45-degree field of view
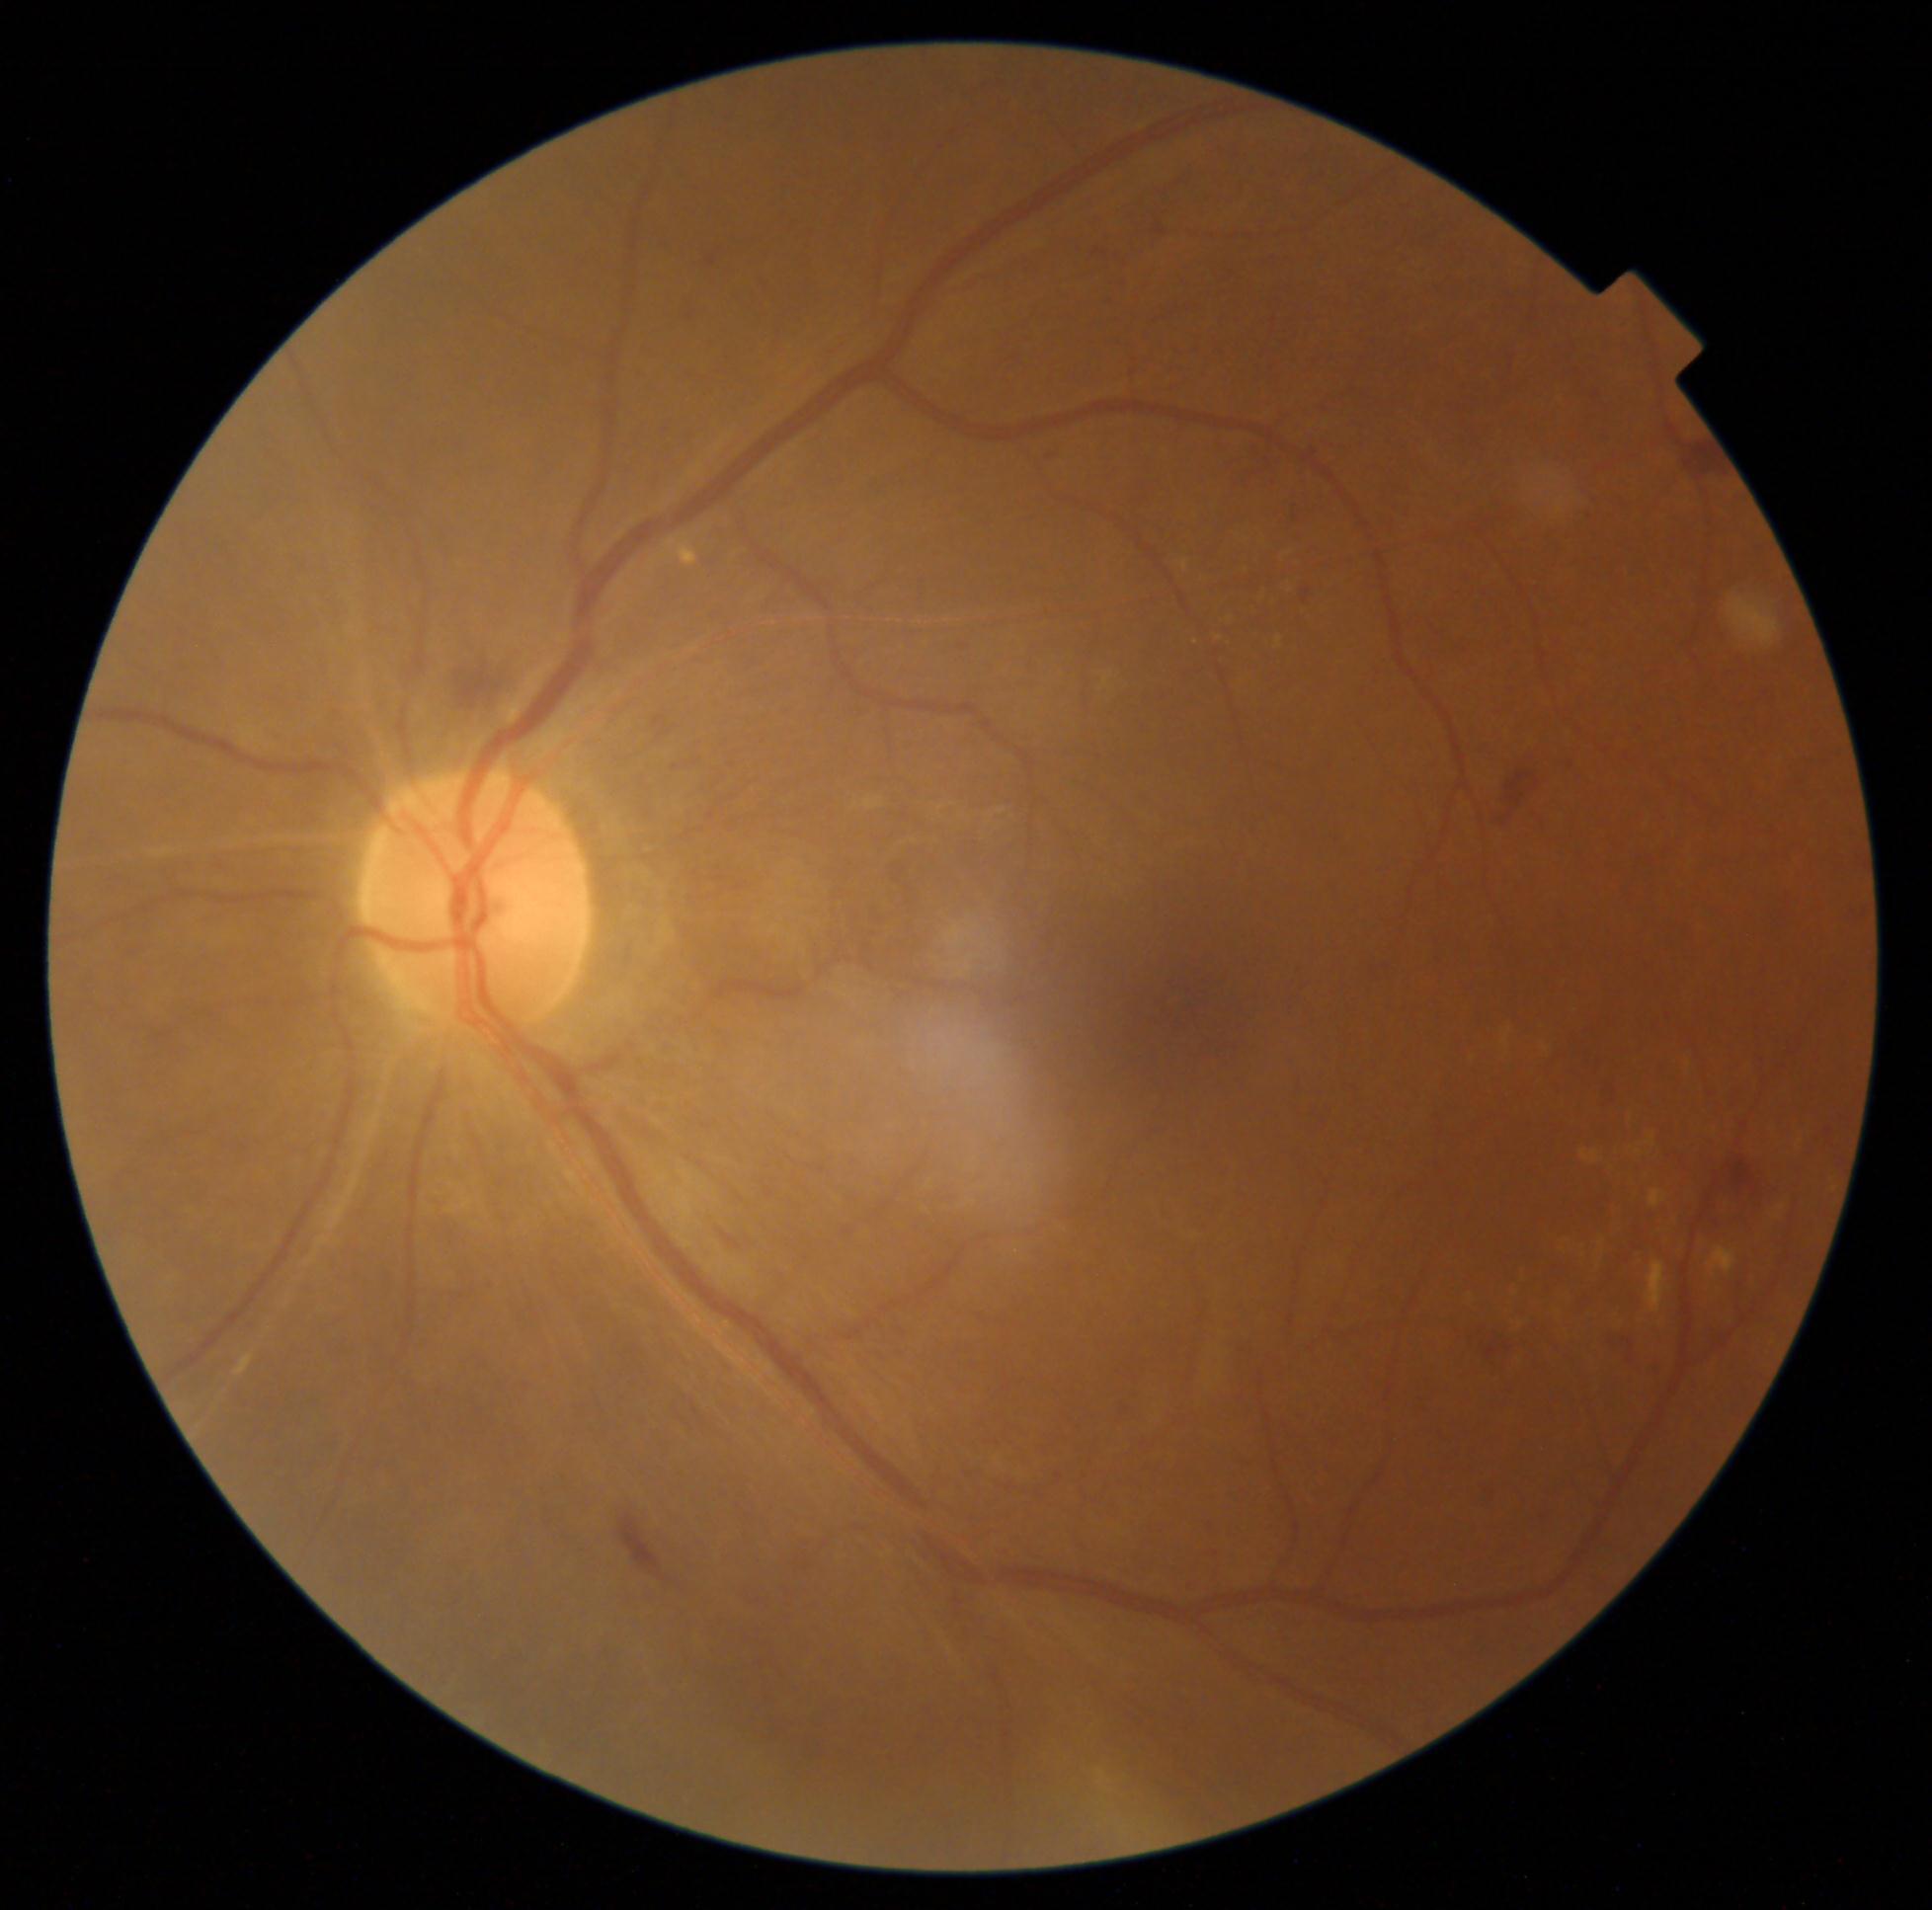 Retinopathy grade: moderate NPDR (2). Hard exudates (partial list) at [1502,1029,1512,1047] | [1647,1262,1666,1313] | [1276,636,1283,650] | [1580,1151,1602,1165] | [1104,675,1111,689] | [1543,1045,1549,1053] | [1598,1240,1606,1245]. Additional small hard exudates near <point>1801, 1143</point> | <point>1521, 1324</point> | <point>1639, 1152</point>.